Retinal fundus photograph: 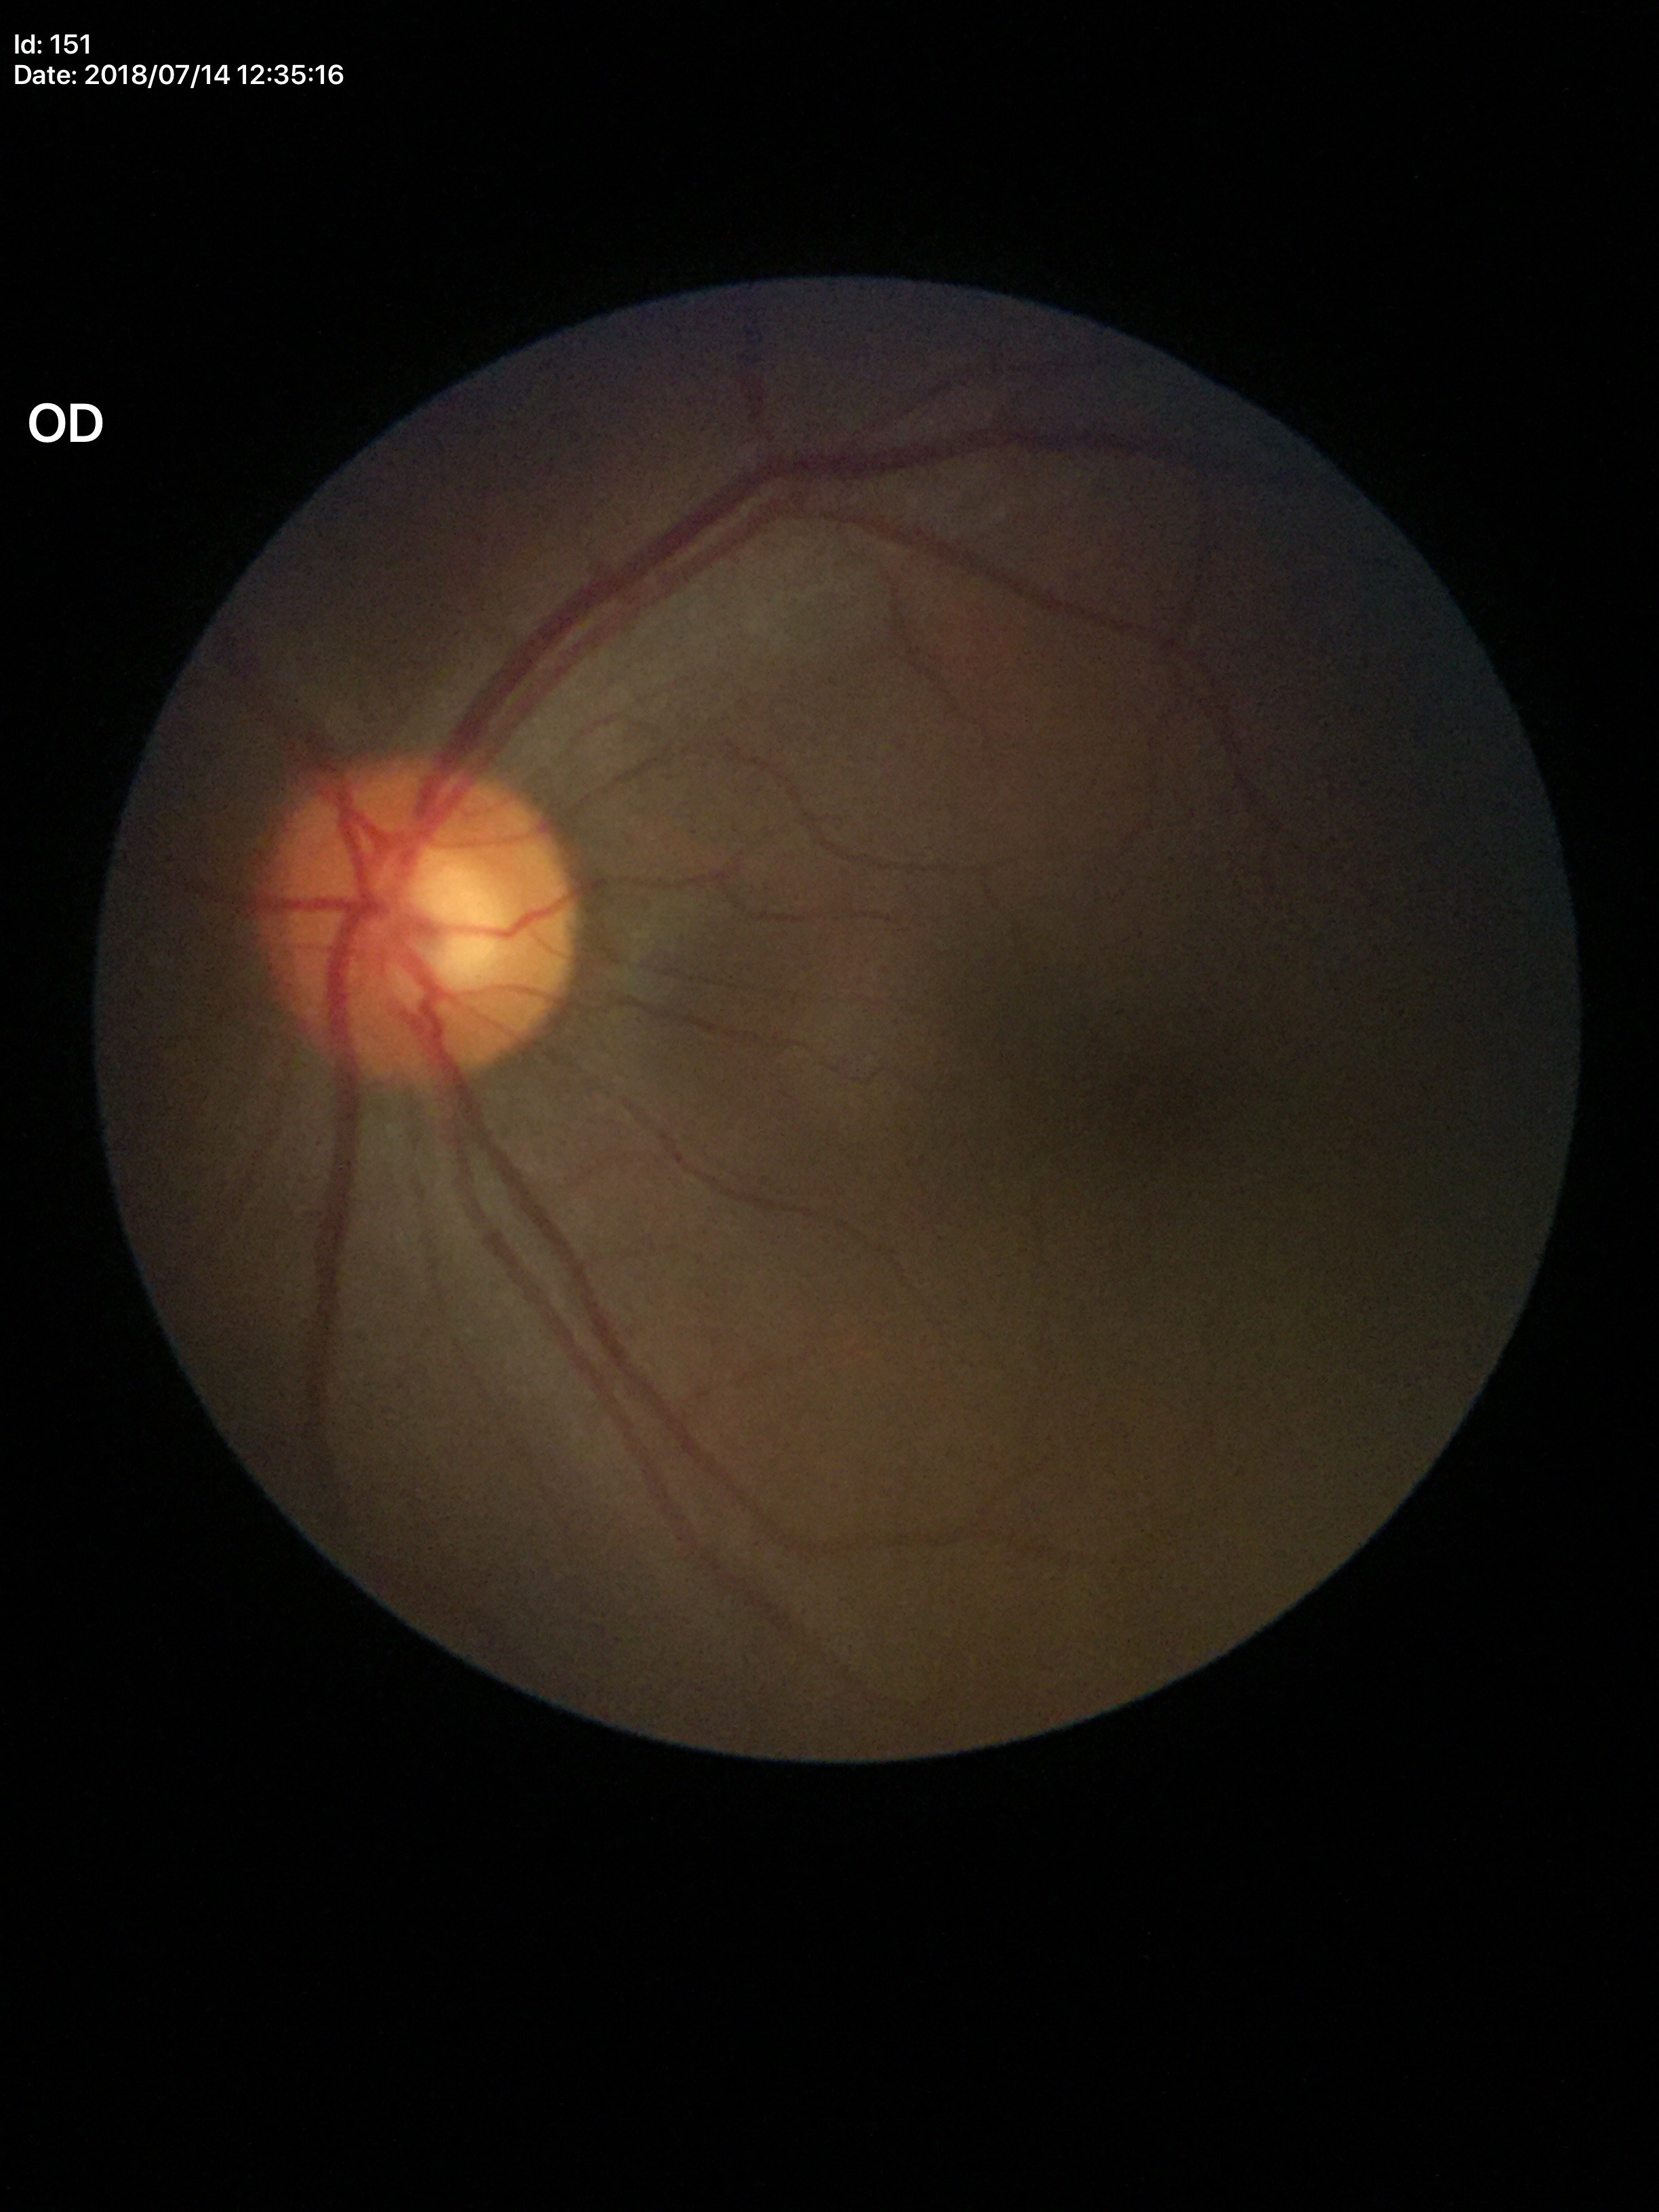
Horizontal C/D ratio: 0.54. Vertical C/D ratio is 0.54. No glaucomatous findings.